Wide-field fundus image from infant ROP screening.
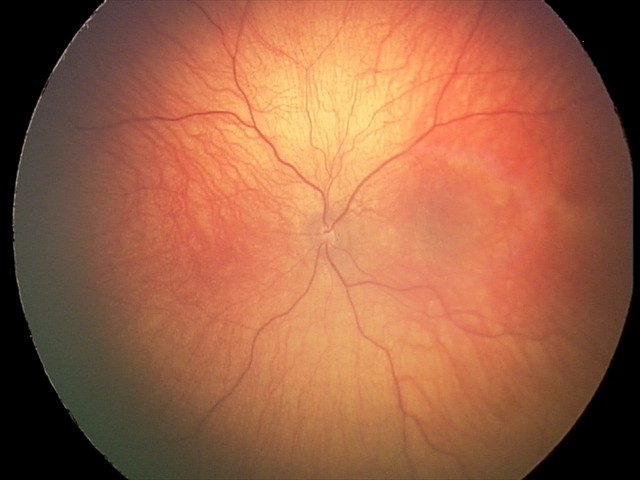 Examination with physiological retinal findings.